RetCam wide-field infant fundus image · 640 x 480 pixels · 130° field of view (Clarity RetCam 3): 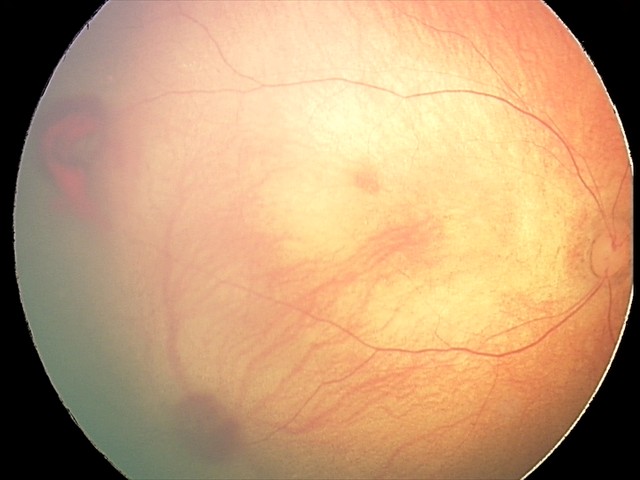 Examination diagnosed as retinal hemorrhages.